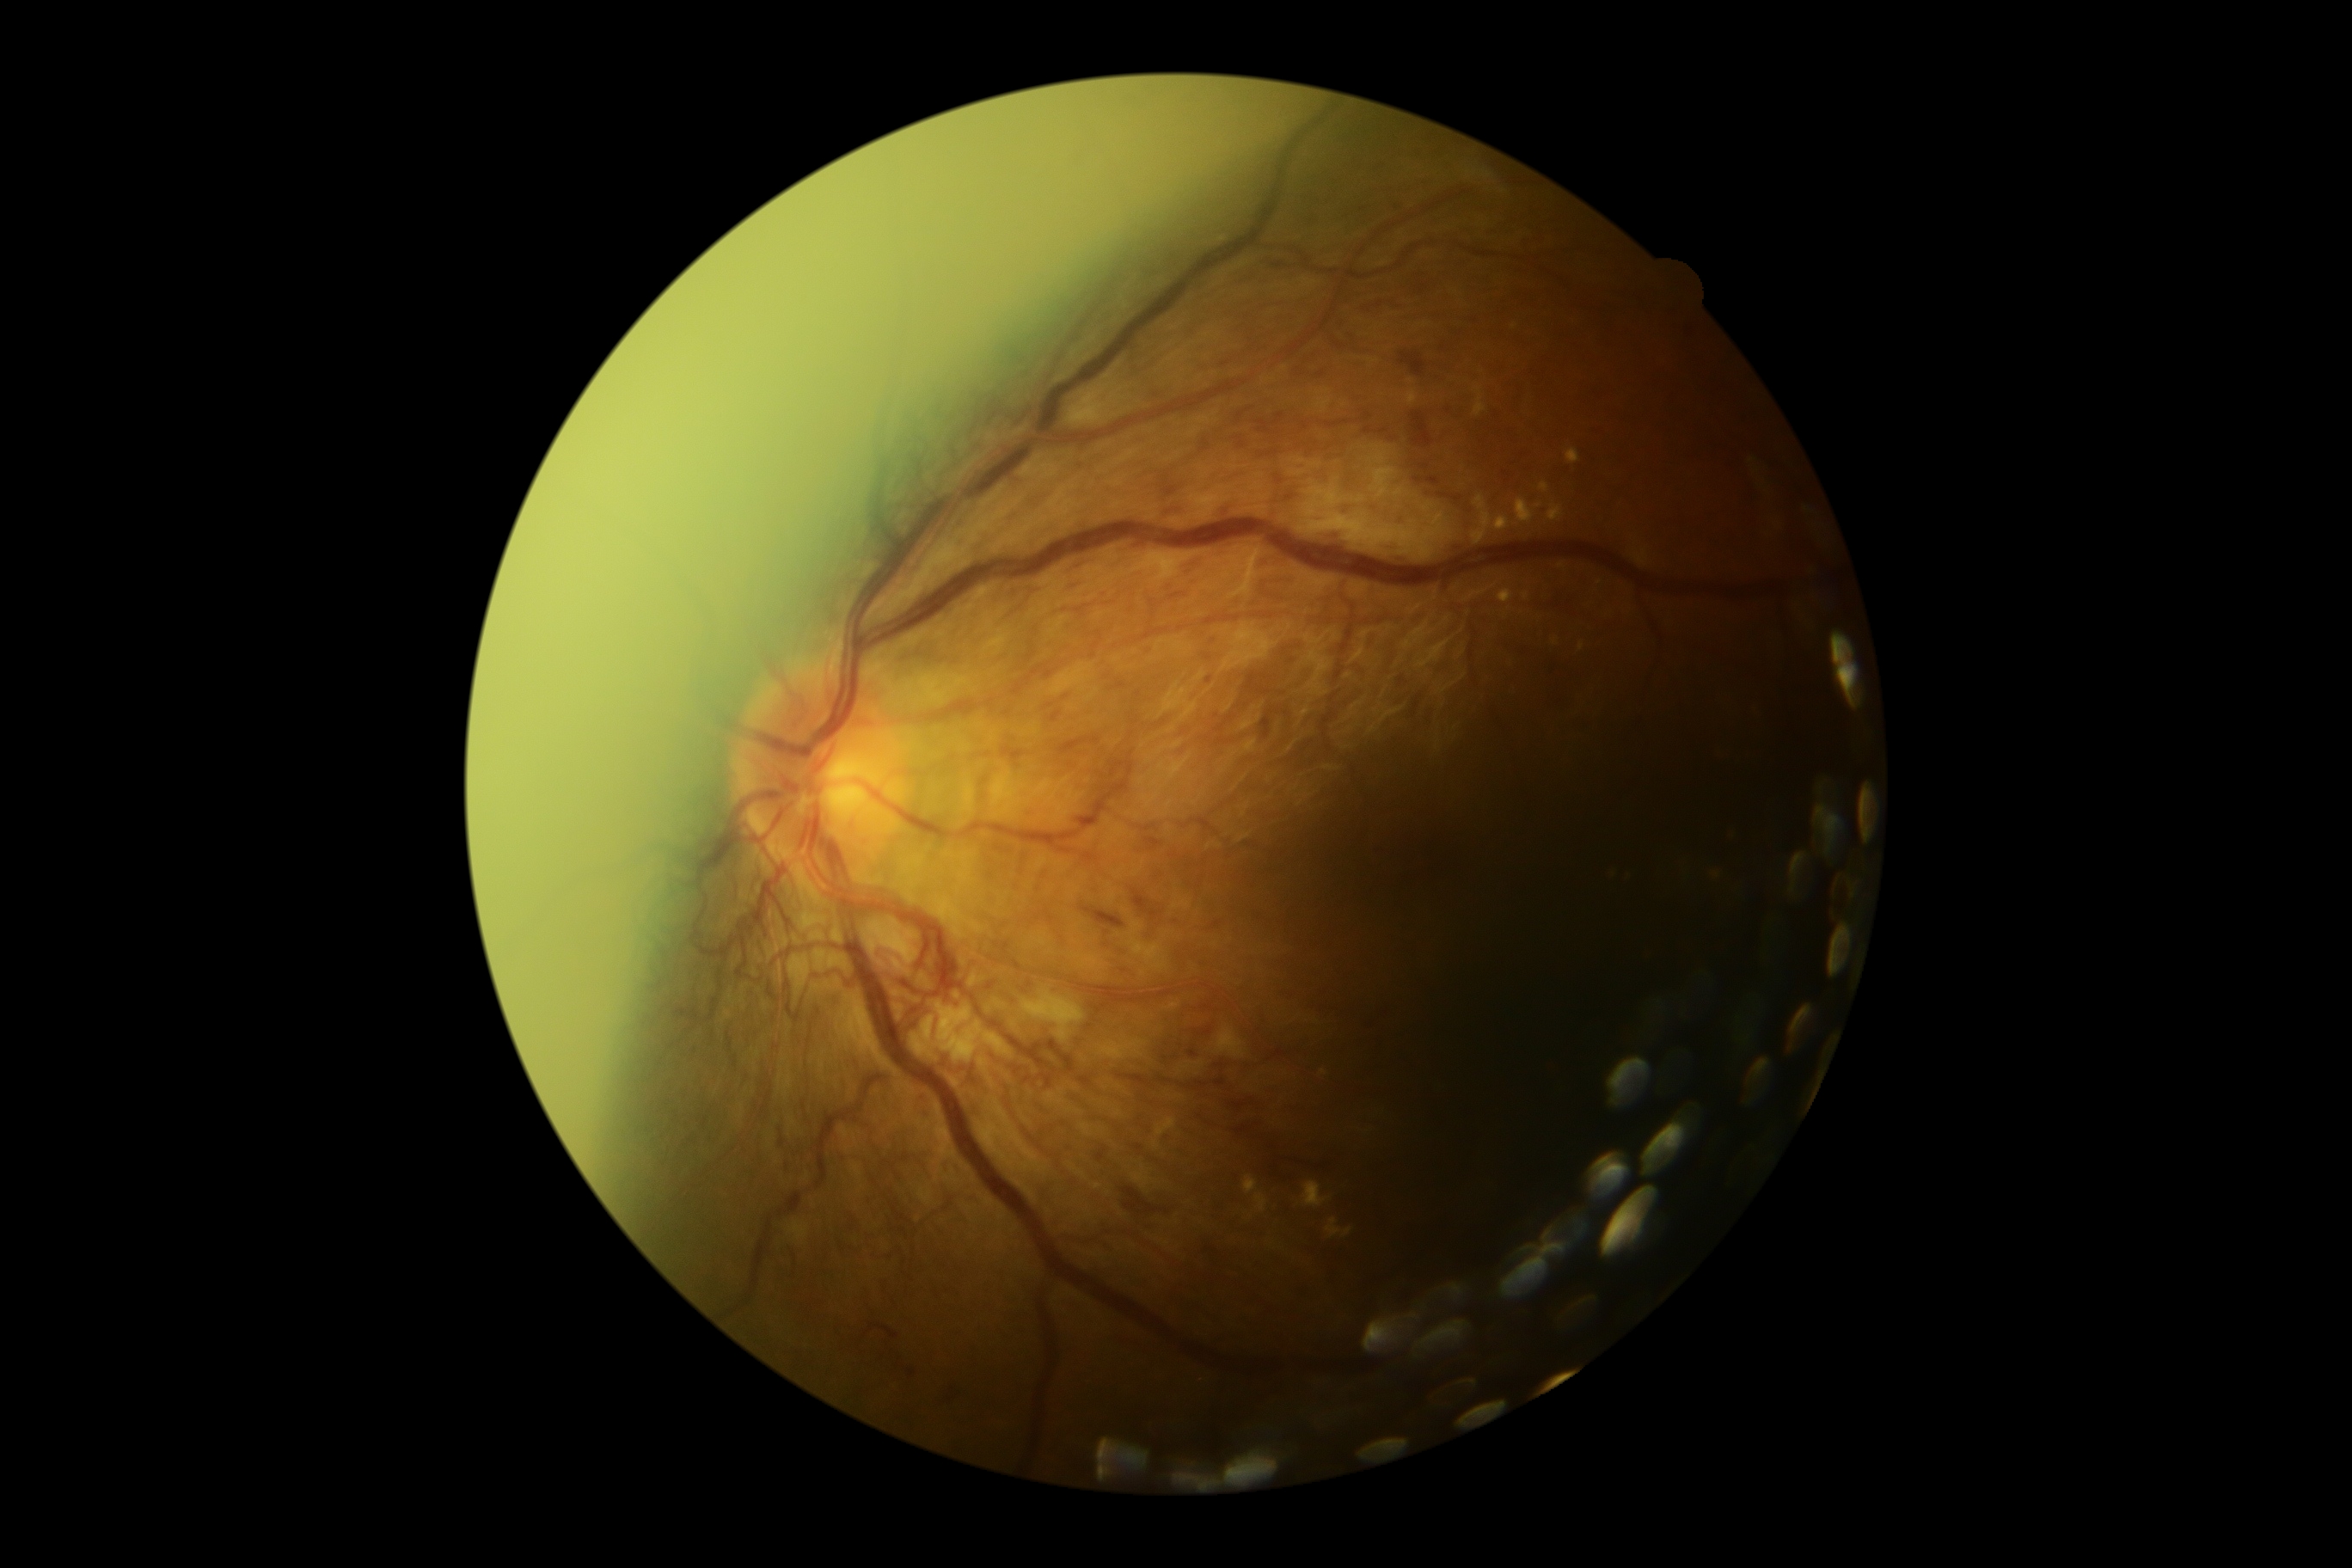

DR stage: grade 4 (PDR) — neovascularization and/or vitreous/pre-retinal hemorrhage.